45-degree field of view. Color fundus image.
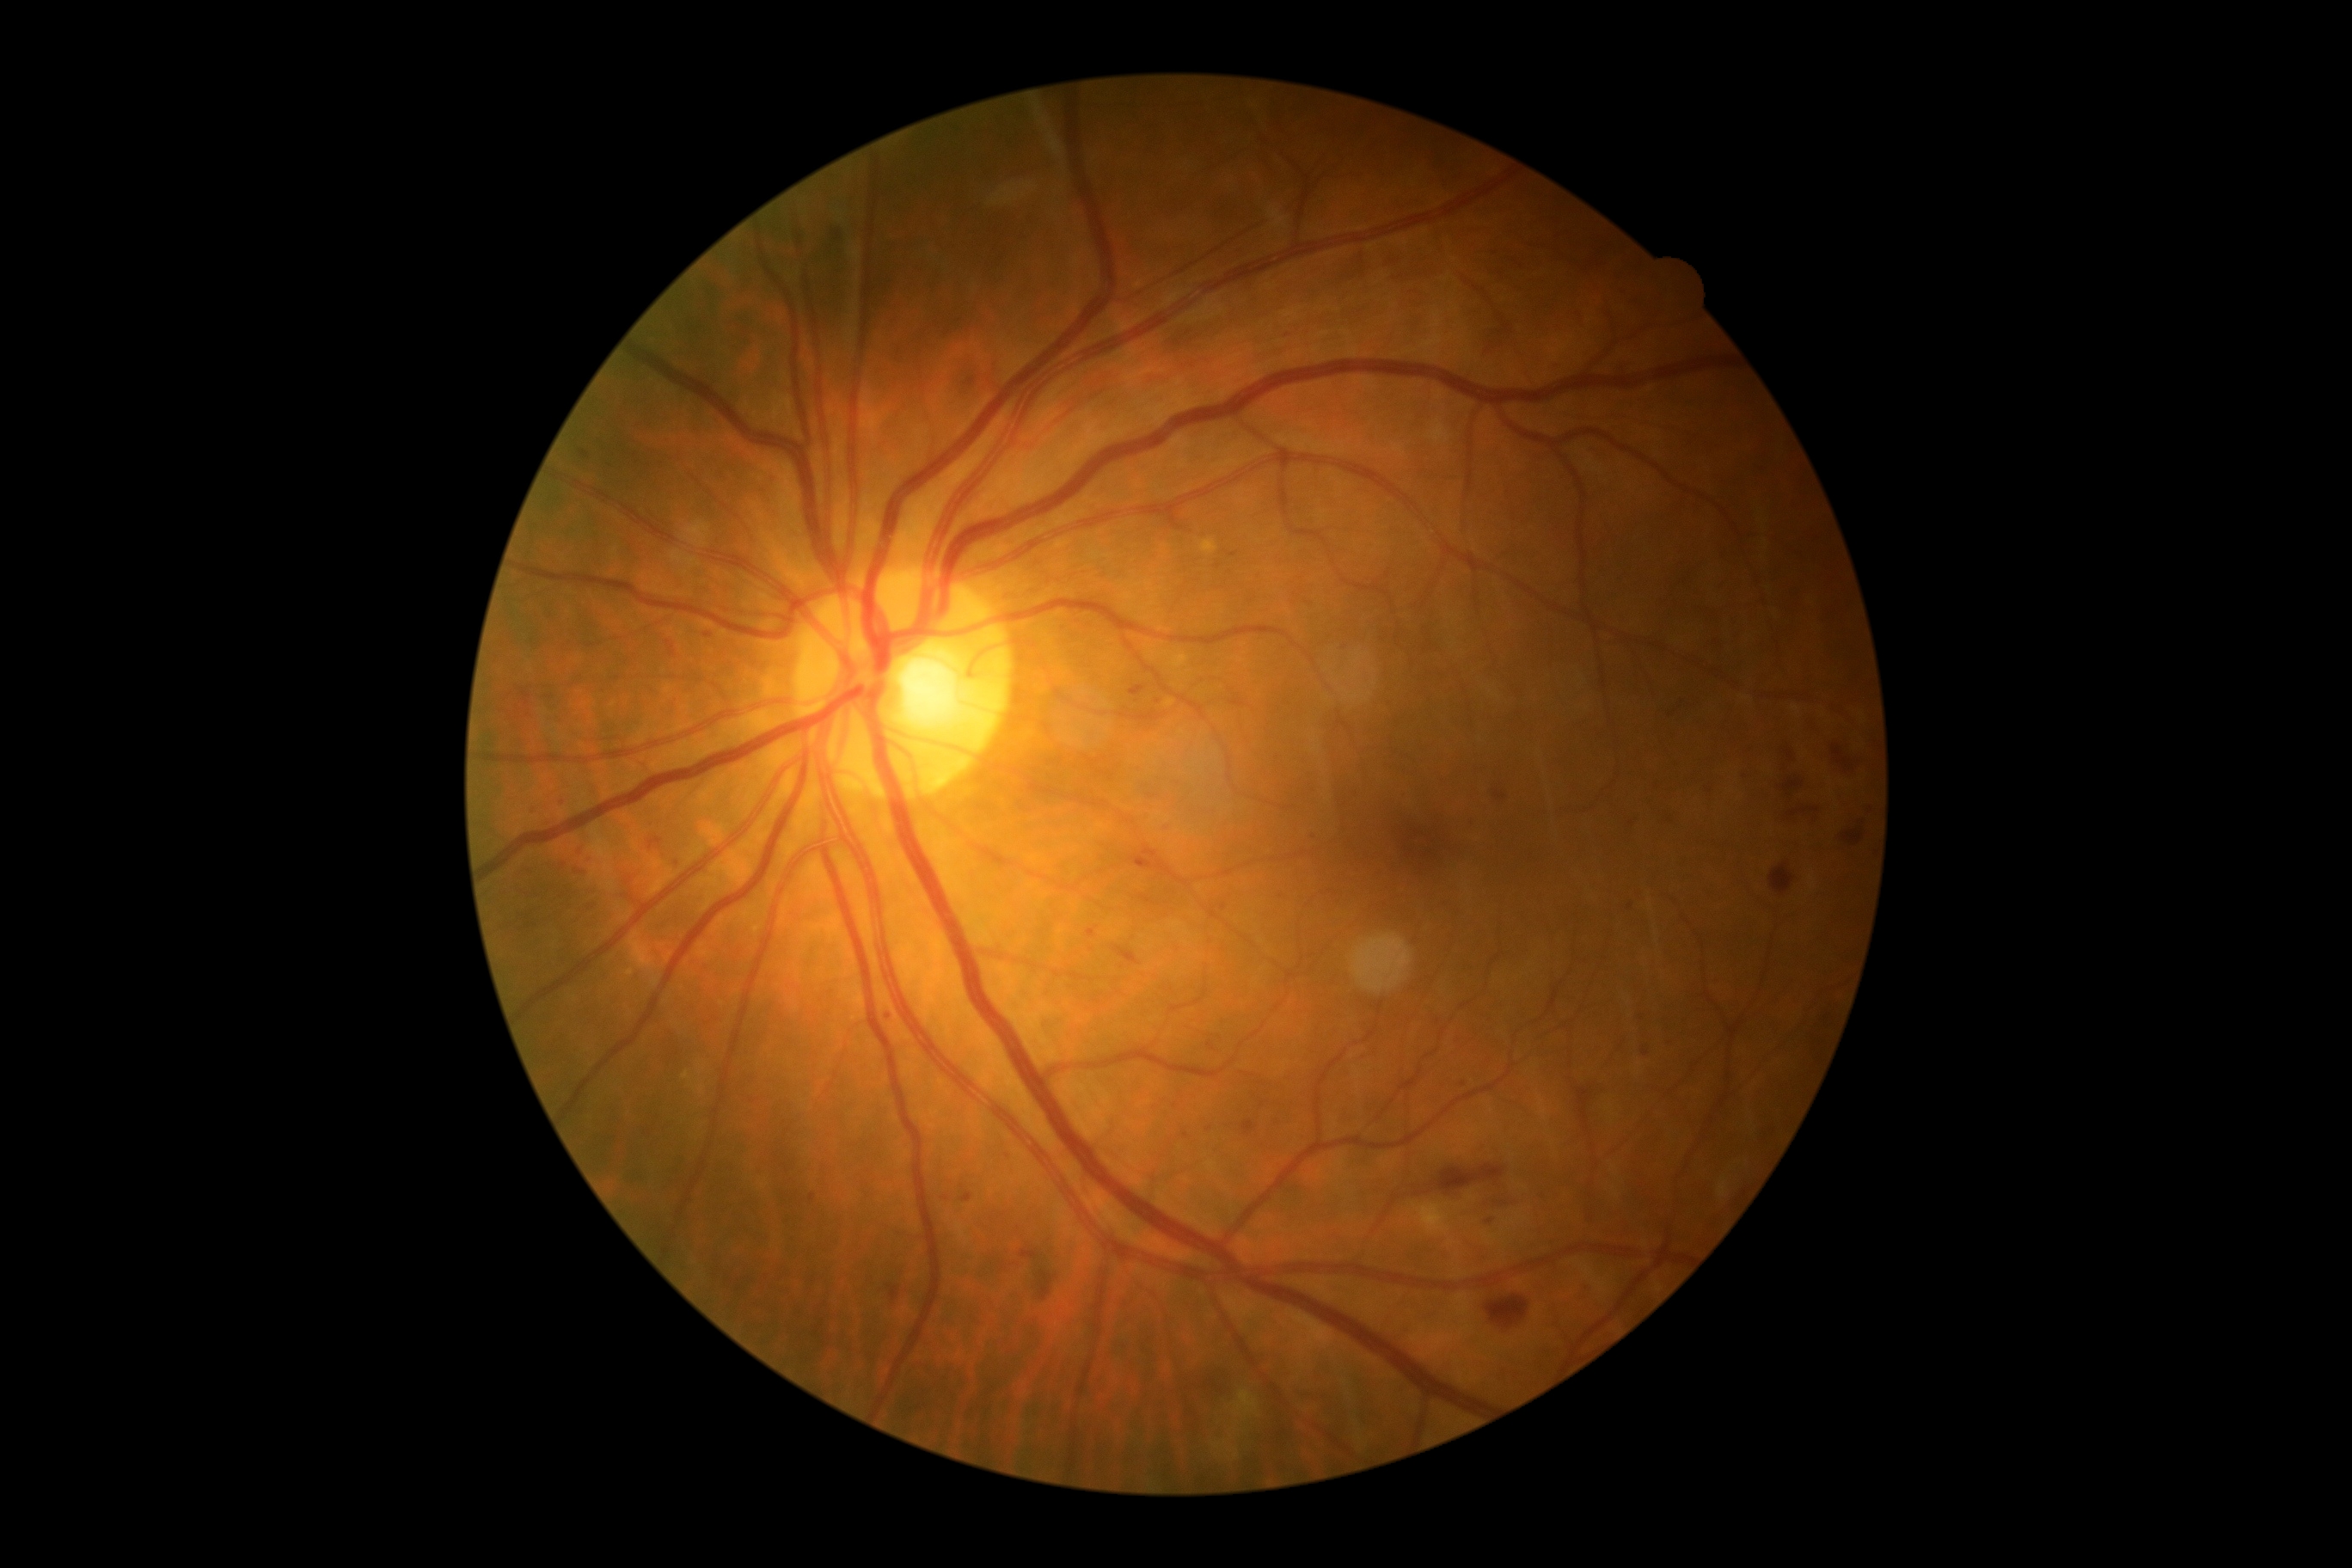 partial: true
dr_grade: 2
lesions:
  ma:
    - <region>1485, 1218, 1495, 1225</region>
    - <region>1493, 790, 1507, 800</region>
    - <region>886, 1283, 900, 1302</region>
    - <region>1230, 553, 1239, 558</region>
    - <region>1208, 1043, 1215, 1051</region>
    - <region>1242, 1122, 1258, 1136</region>
    - <region>965, 377, 976, 386</region>
    - <region>1087, 928, 1098, 940</region>
    - <region>575, 871, 584, 874</region>
  ma_small:
    - {"x": 1158, "y": 702}
    - {"x": 1208, "y": 1129}
    - {"x": 1219, "y": 566}
    - {"x": 812, "y": 1199}
    - {"x": 1008, "y": 1156}
  he:
    - <region>1112, 946, 1141, 965</region>
    - <region>1038, 1270, 1058, 1302</region>
    - <region>1832, 744, 1856, 773</region>
    - <region>1129, 845, 1189, 886</region>
    - <region>1784, 747, 1796, 763</region>
    - <region>1784, 778, 1804, 797</region>
    - <region>1770, 862, 1796, 897</region>
    - <region>1789, 807, 1820, 818</region>
    - <region>1485, 1295, 1529, 1328</region>
    - <region>1842, 828, 1865, 845</region>
    - <region>1433, 1165, 1507, 1196</region>
    - <region>1020, 1251, 1038, 1259</region>
  ex:
    - <region>1418, 1203, 1452, 1235</region>
  se:
    - <region>1234, 1390, 1258, 1418</region>
    - <region>1228, 1449, 1239, 1459</region>
    - <region>1213, 1442, 1227, 1450</region>
  se_small:
    - {"x": 1237, "y": 1431}
    - {"x": 1232, "y": 1438}